45-degree field of view. 1932 x 1916 pixels. CFP.
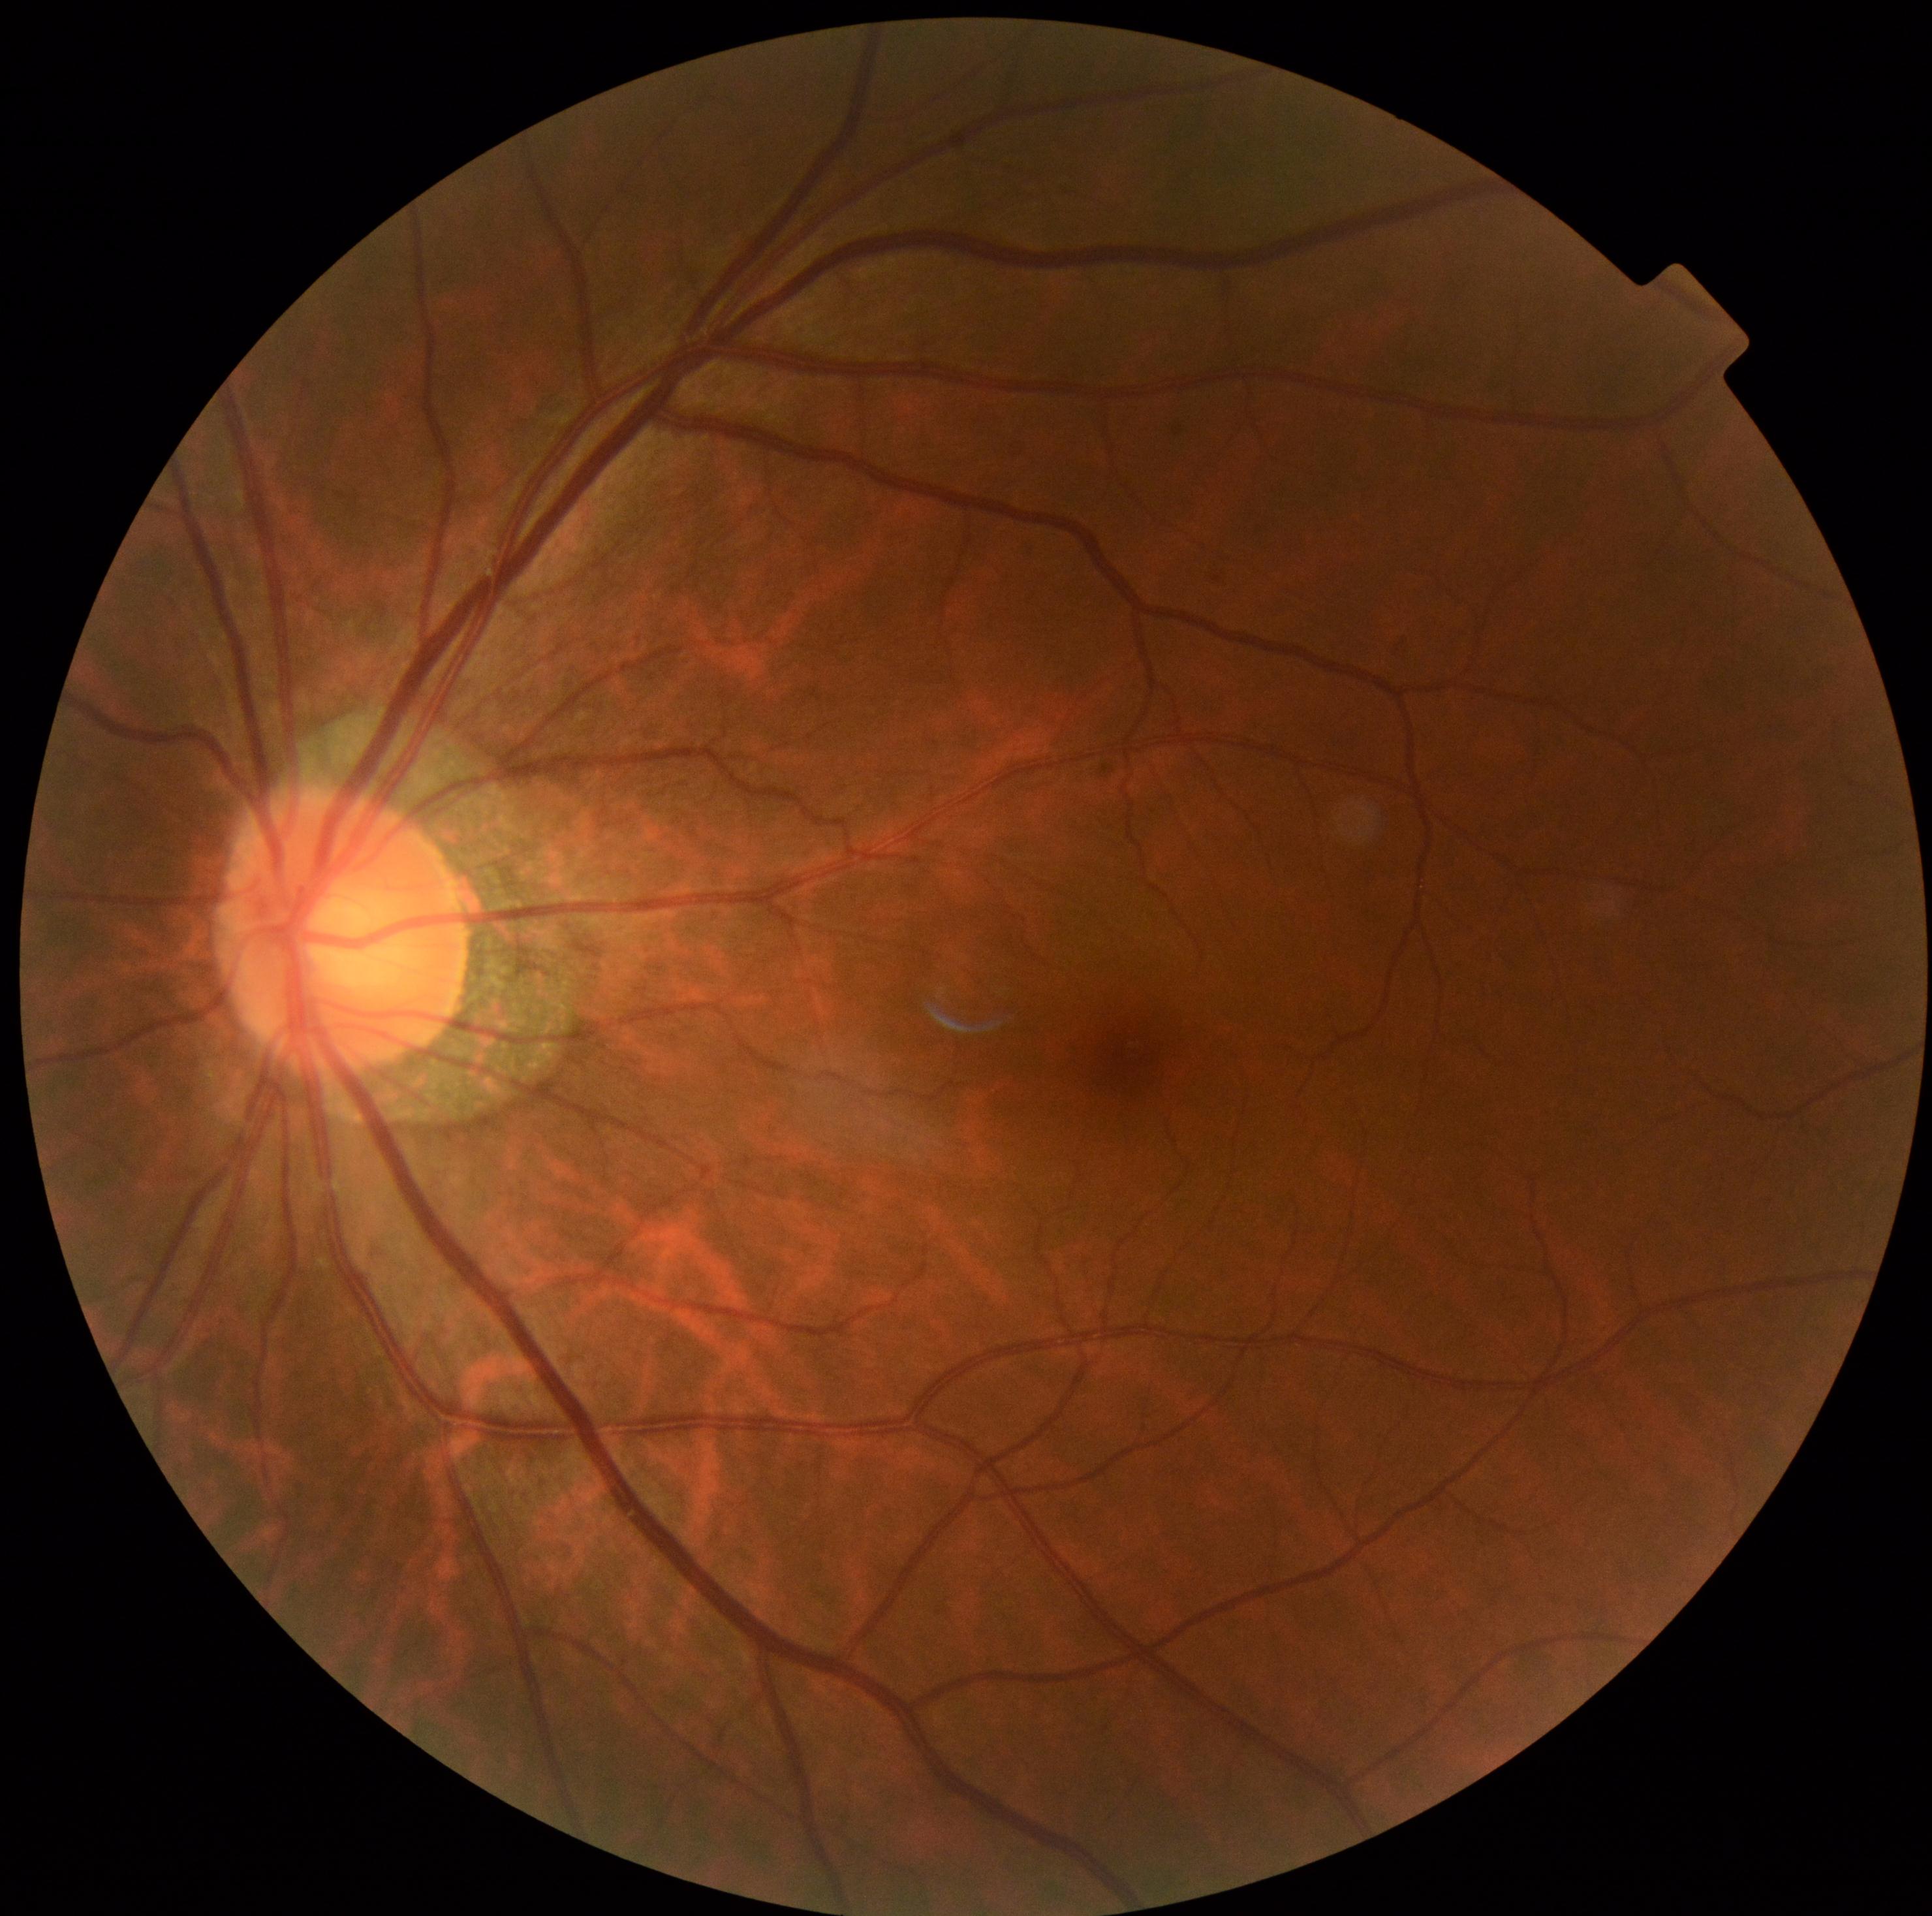
  dr_grade: 0
  dr_impression: no signs of DR